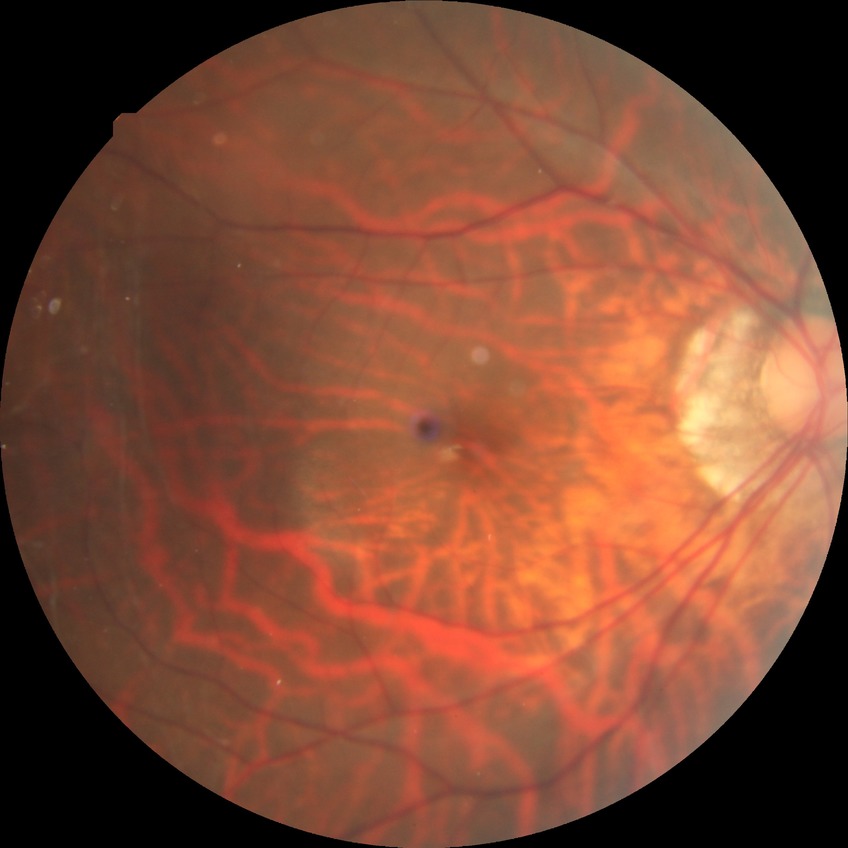
Diabetic retinopathy (DR) is no diabetic retinopathy (NDR).